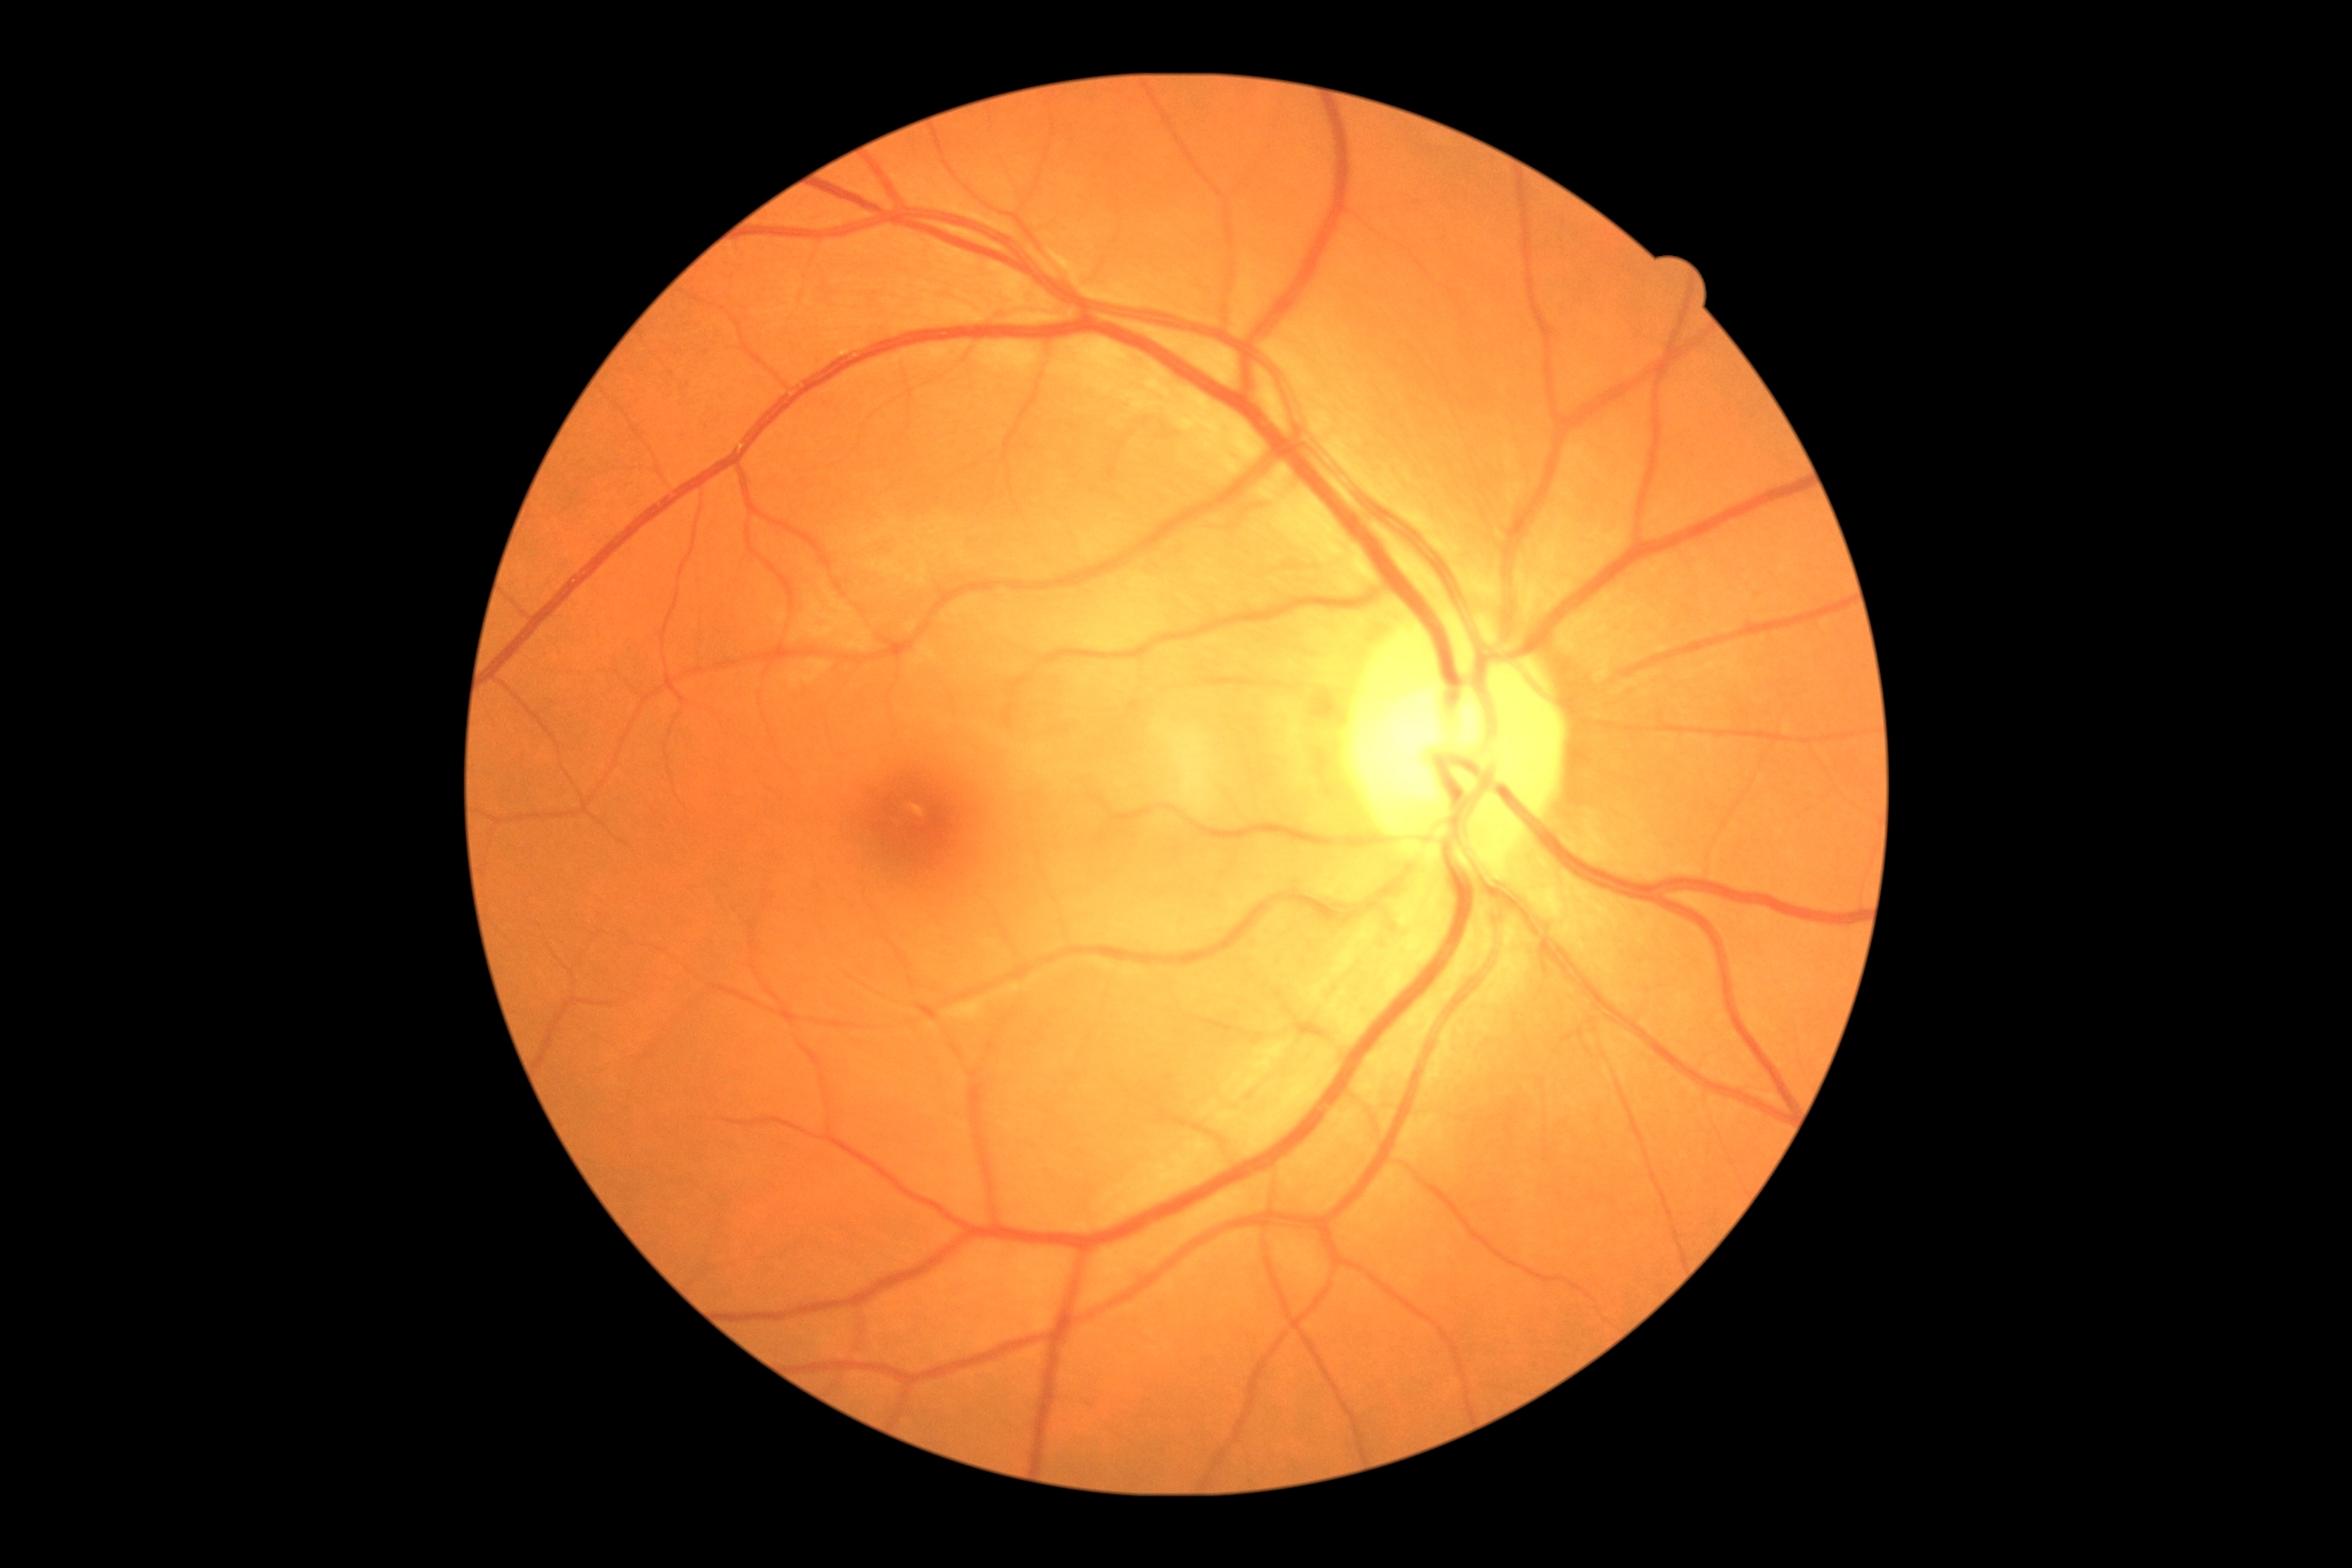

DR is grade 0 — no visible signs of diabetic retinopathy.